512x512, retinal fundus photograph:
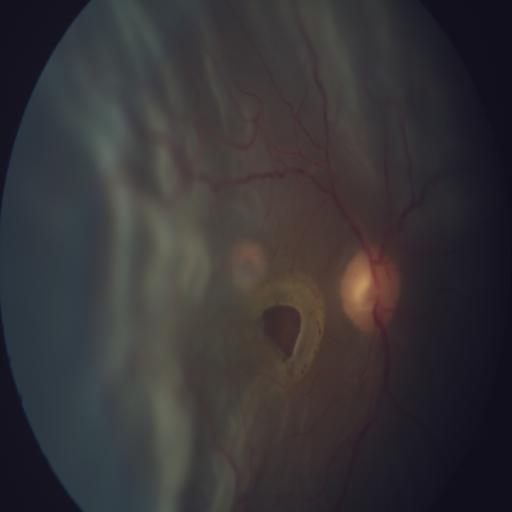
There is evidence of RD (retinal detachment).